45-degree field of view
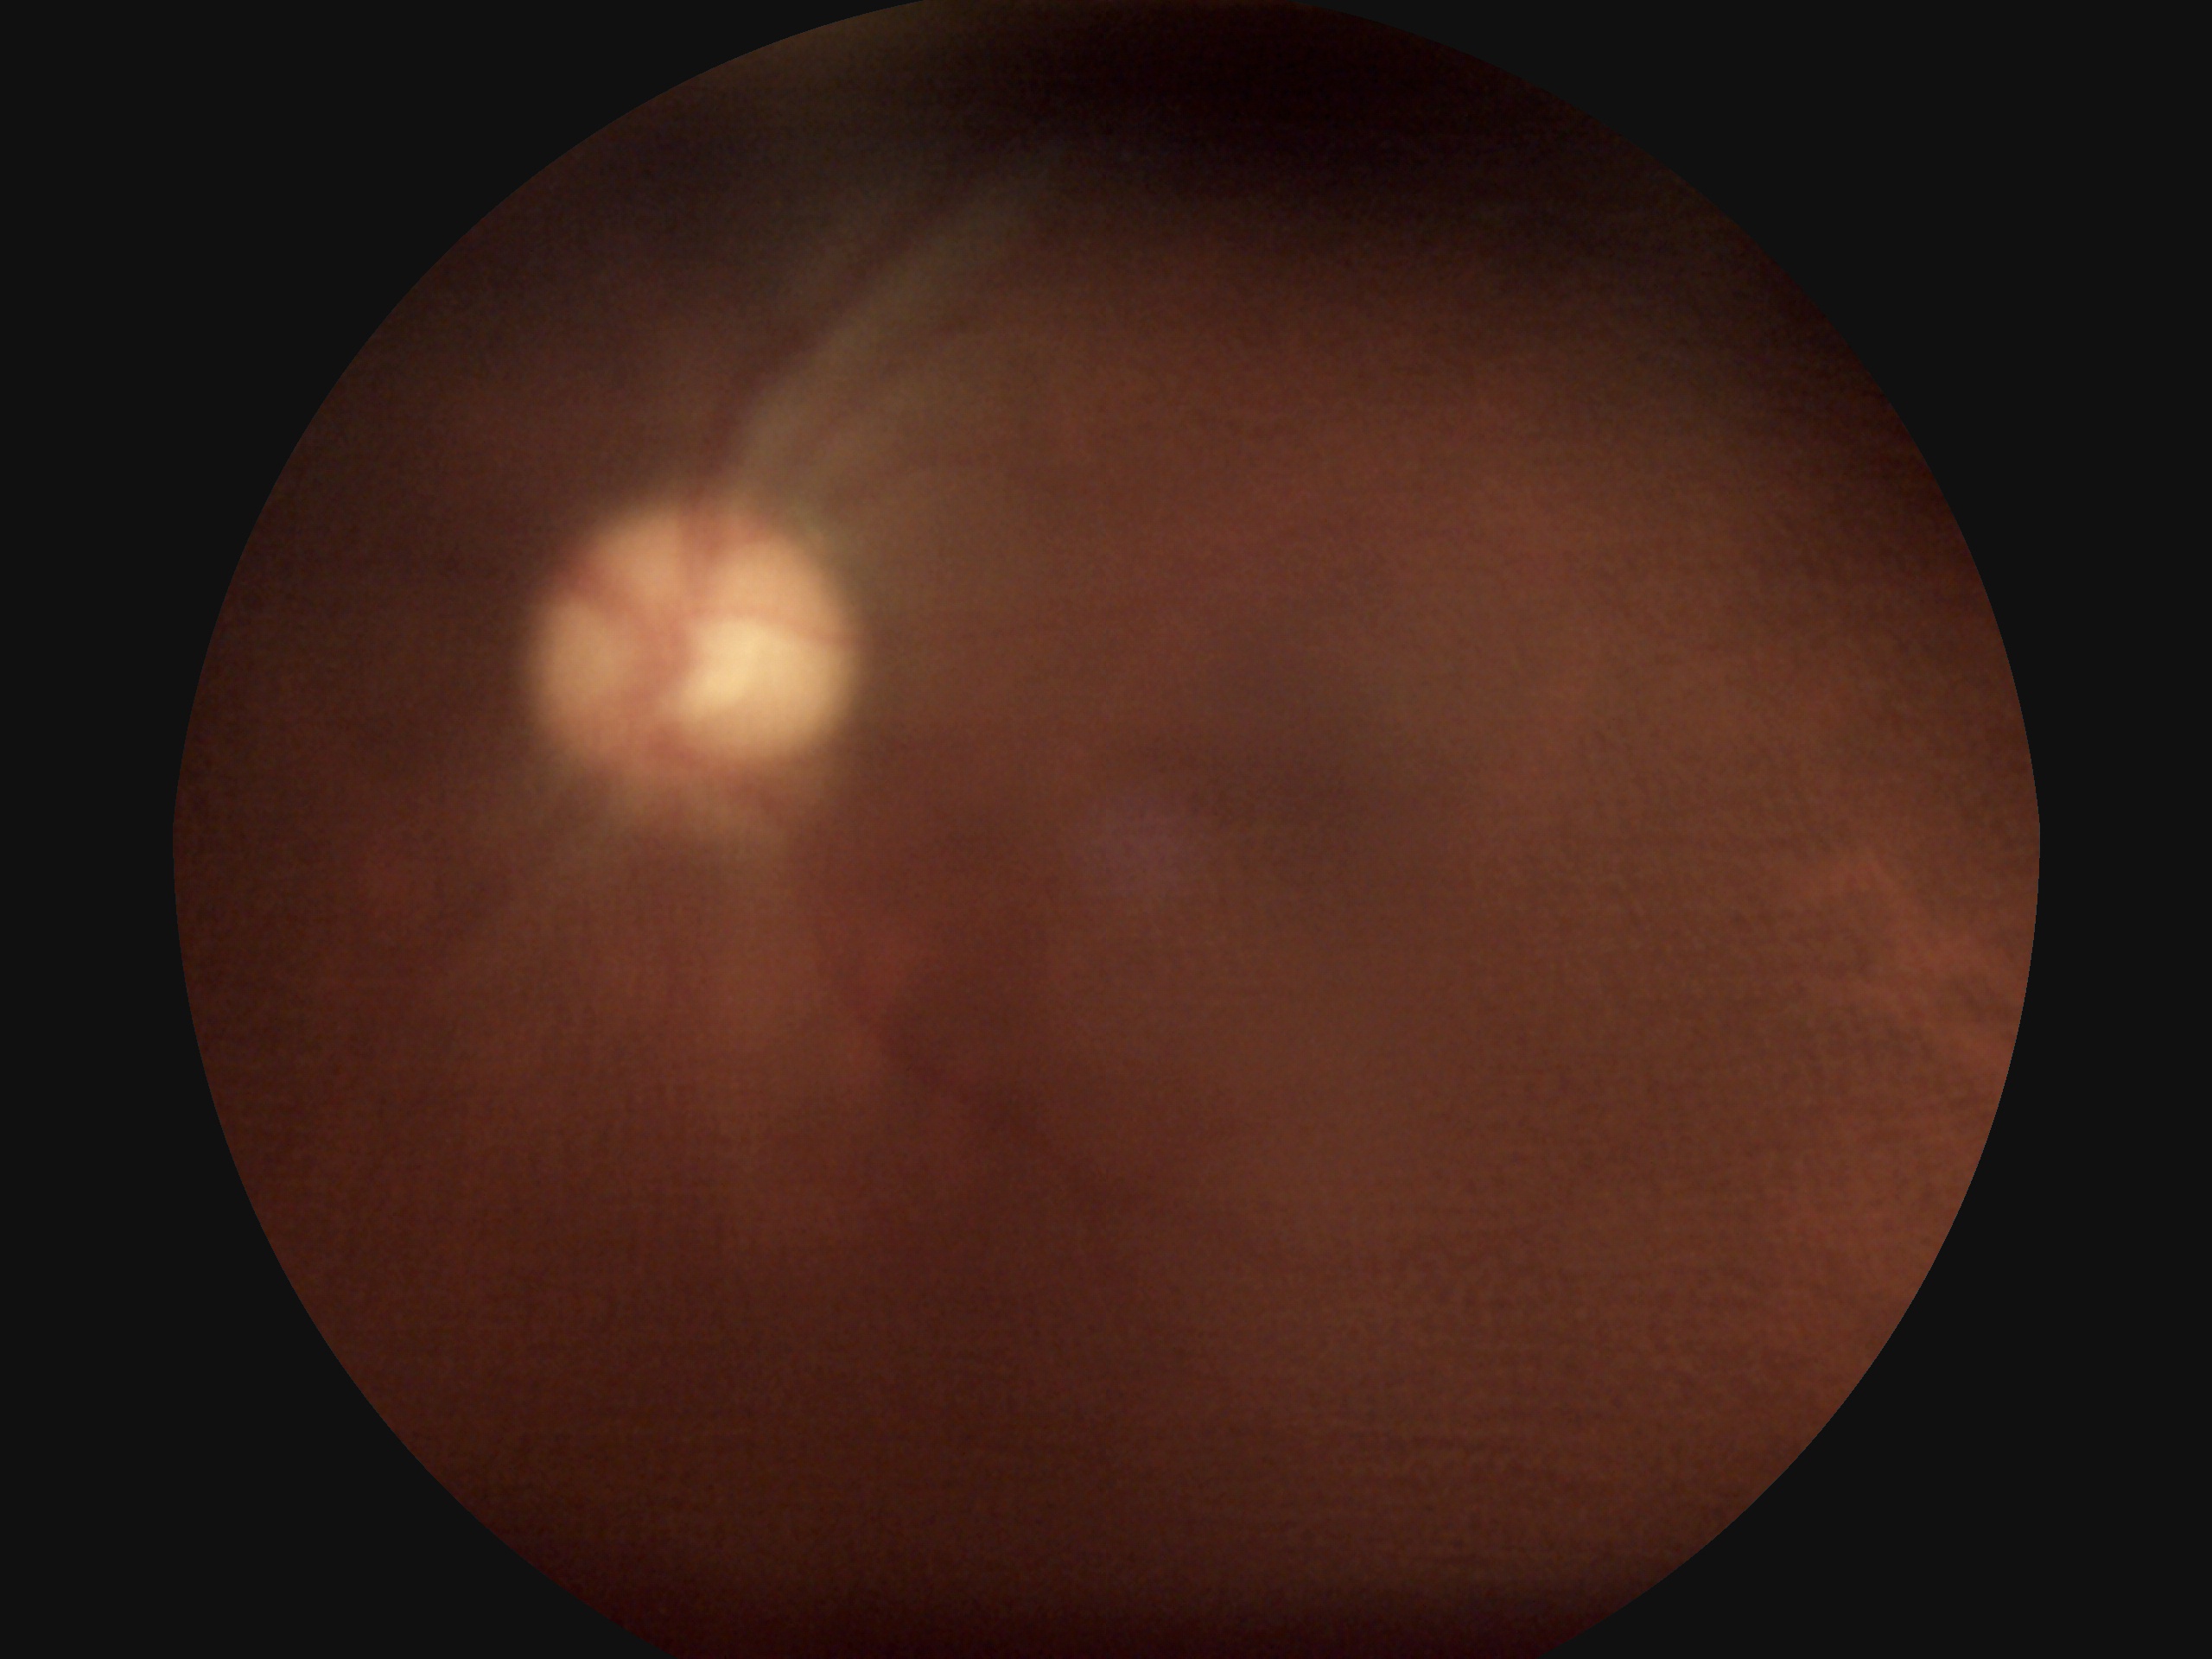

Findings:
- diabetic retinopathy grade — ungradable due to poor image quality
- image quality — too poor for DR grading